45° FOV — 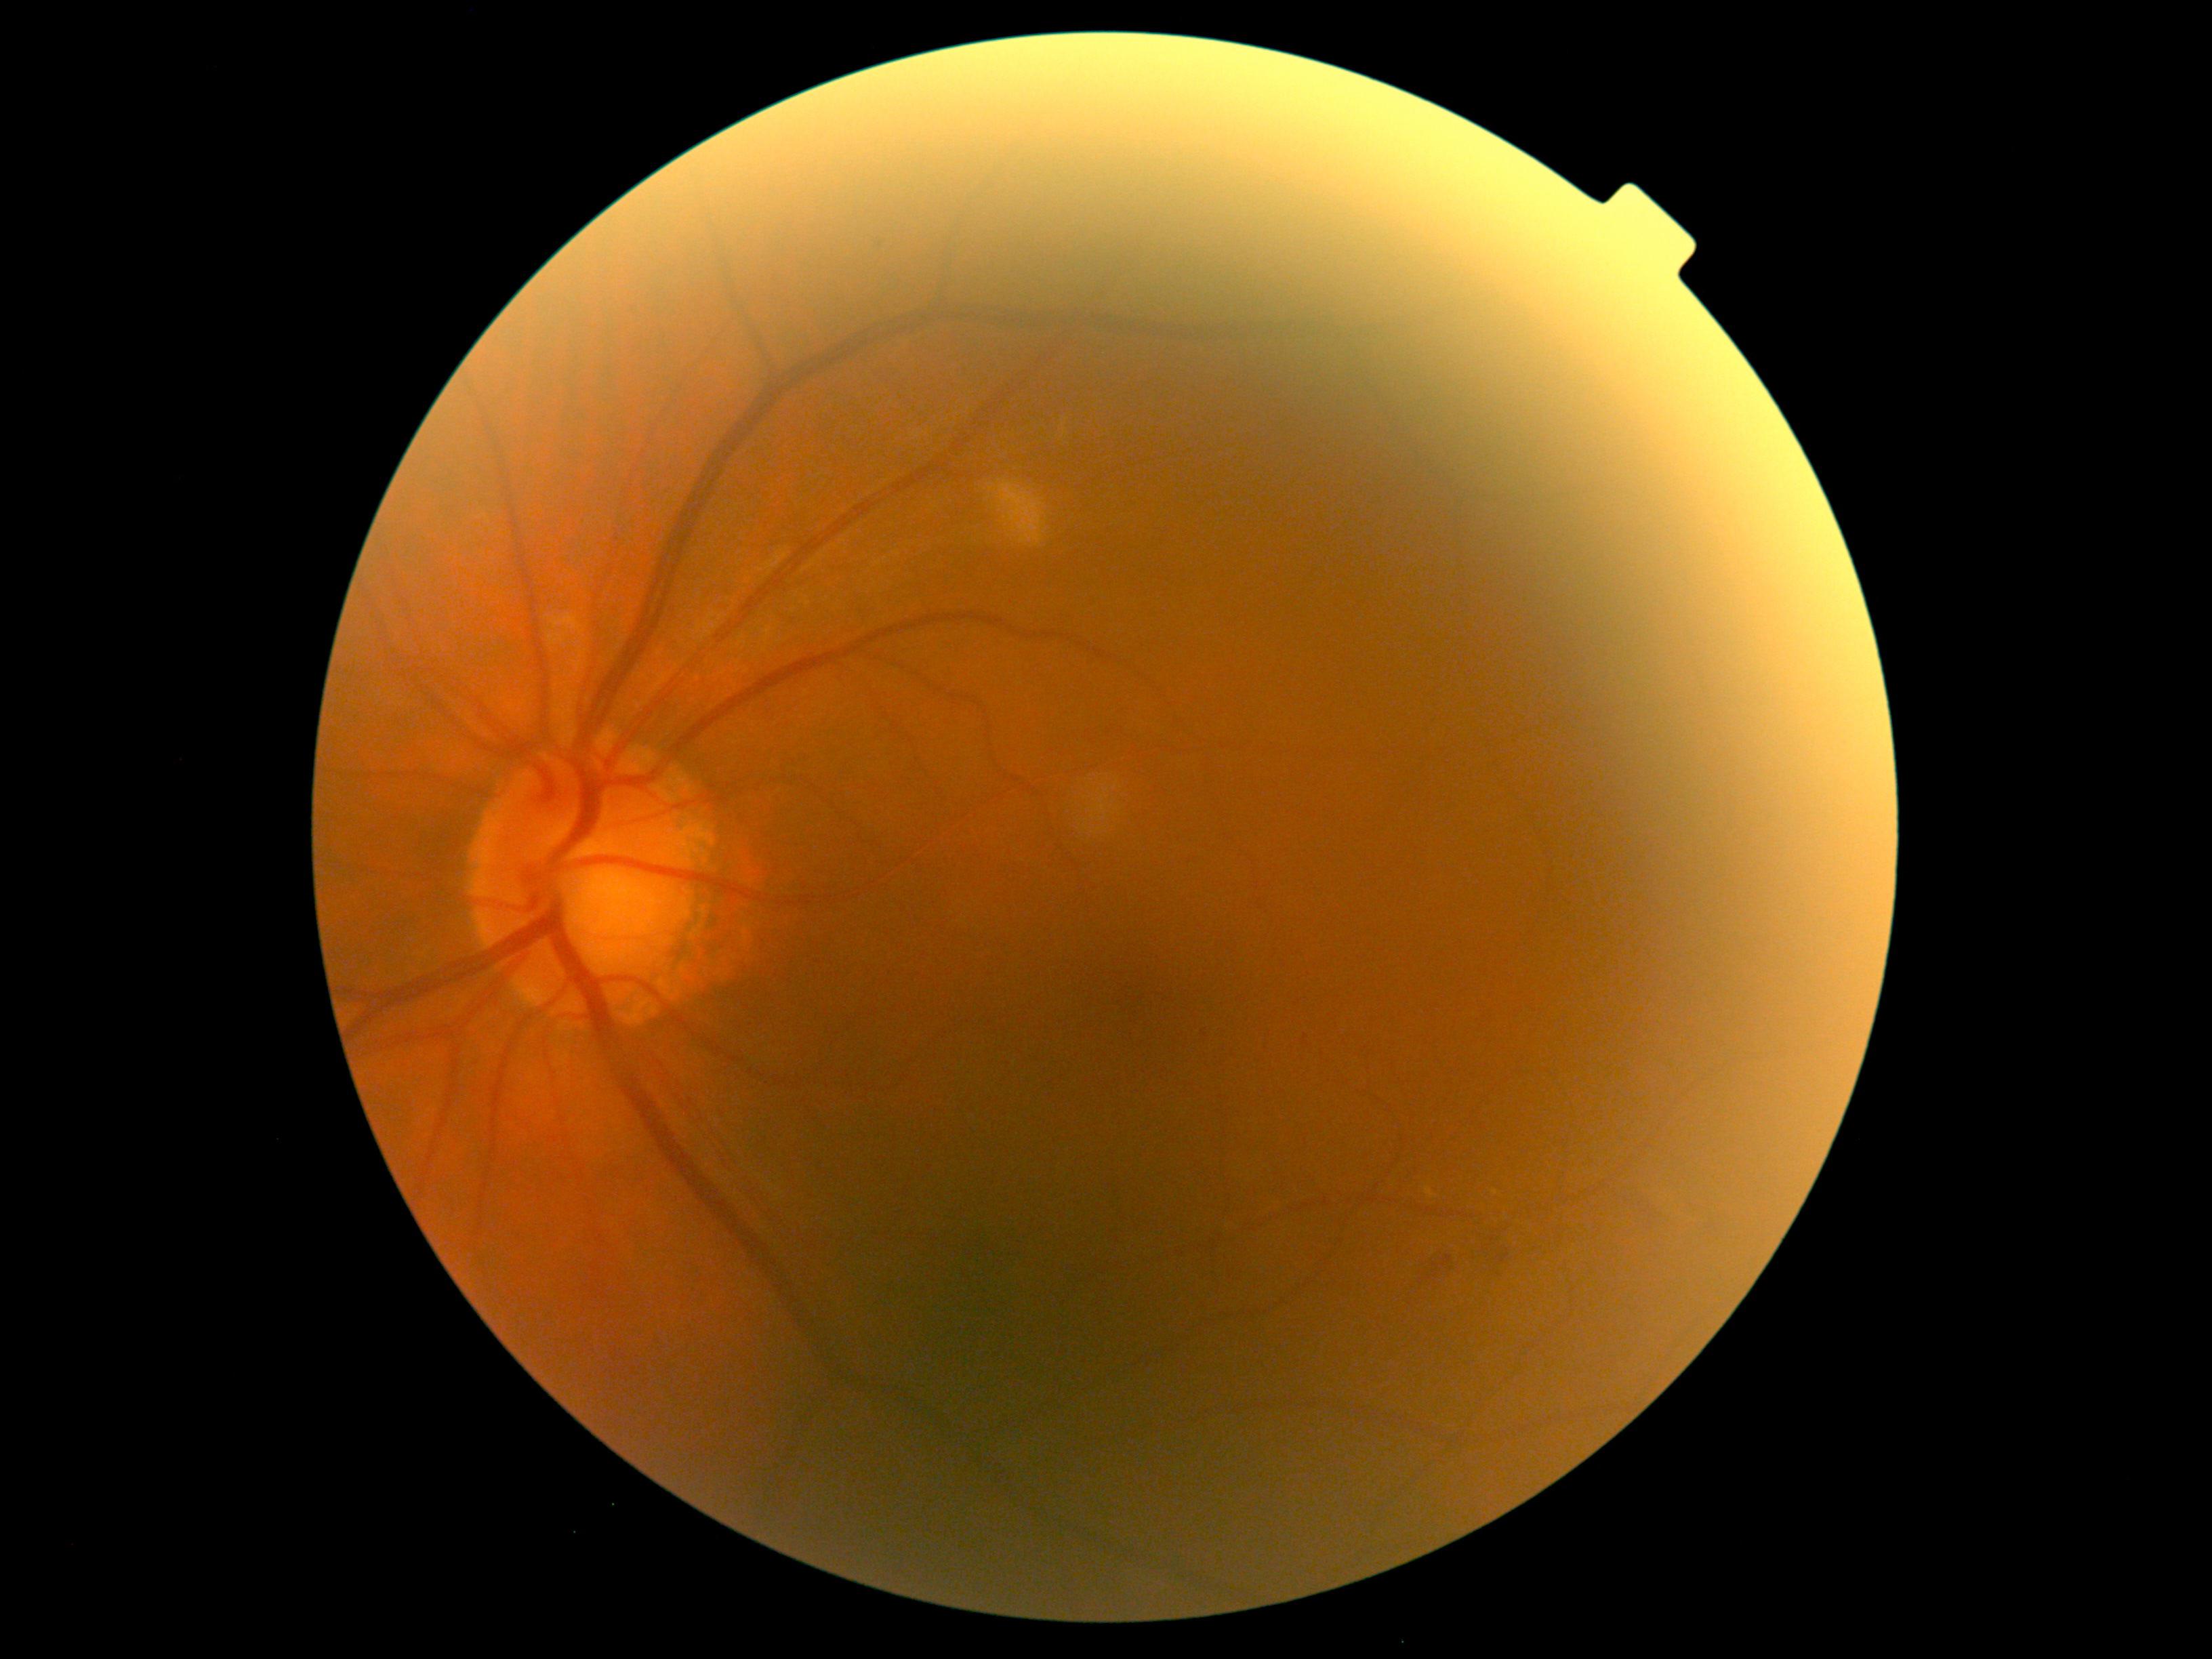 The retinopathy is classified as non-proliferative diabetic retinopathy.
DR severity: grade 2.